Posterior pole photograph · 45-degree field of view.
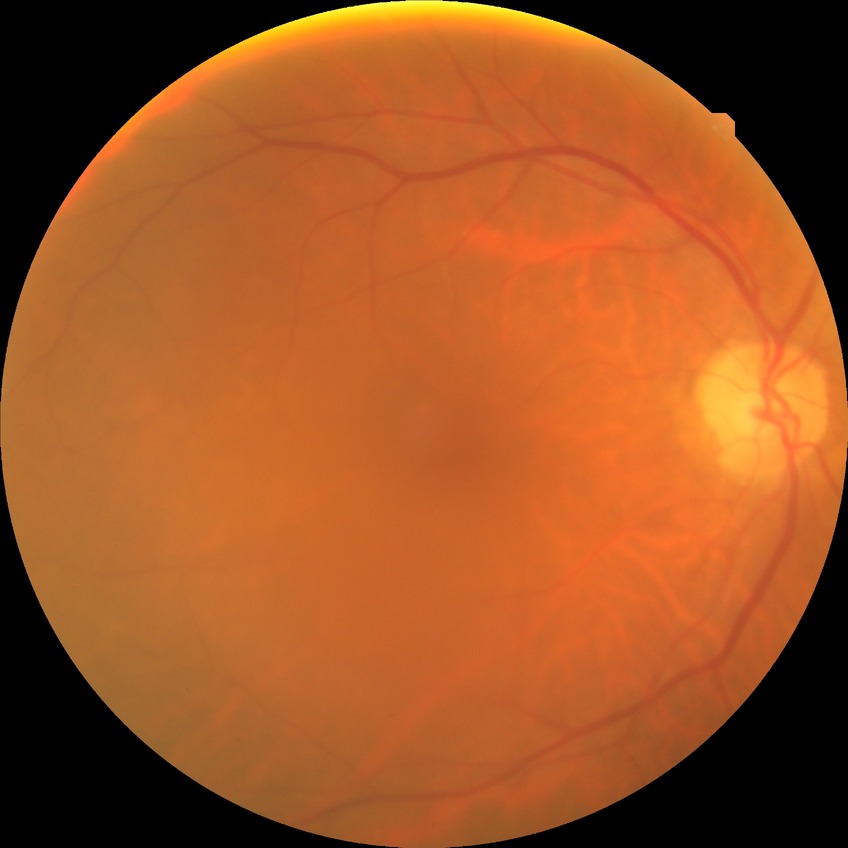 {"davis_grade": "no diabetic retinopathy"}